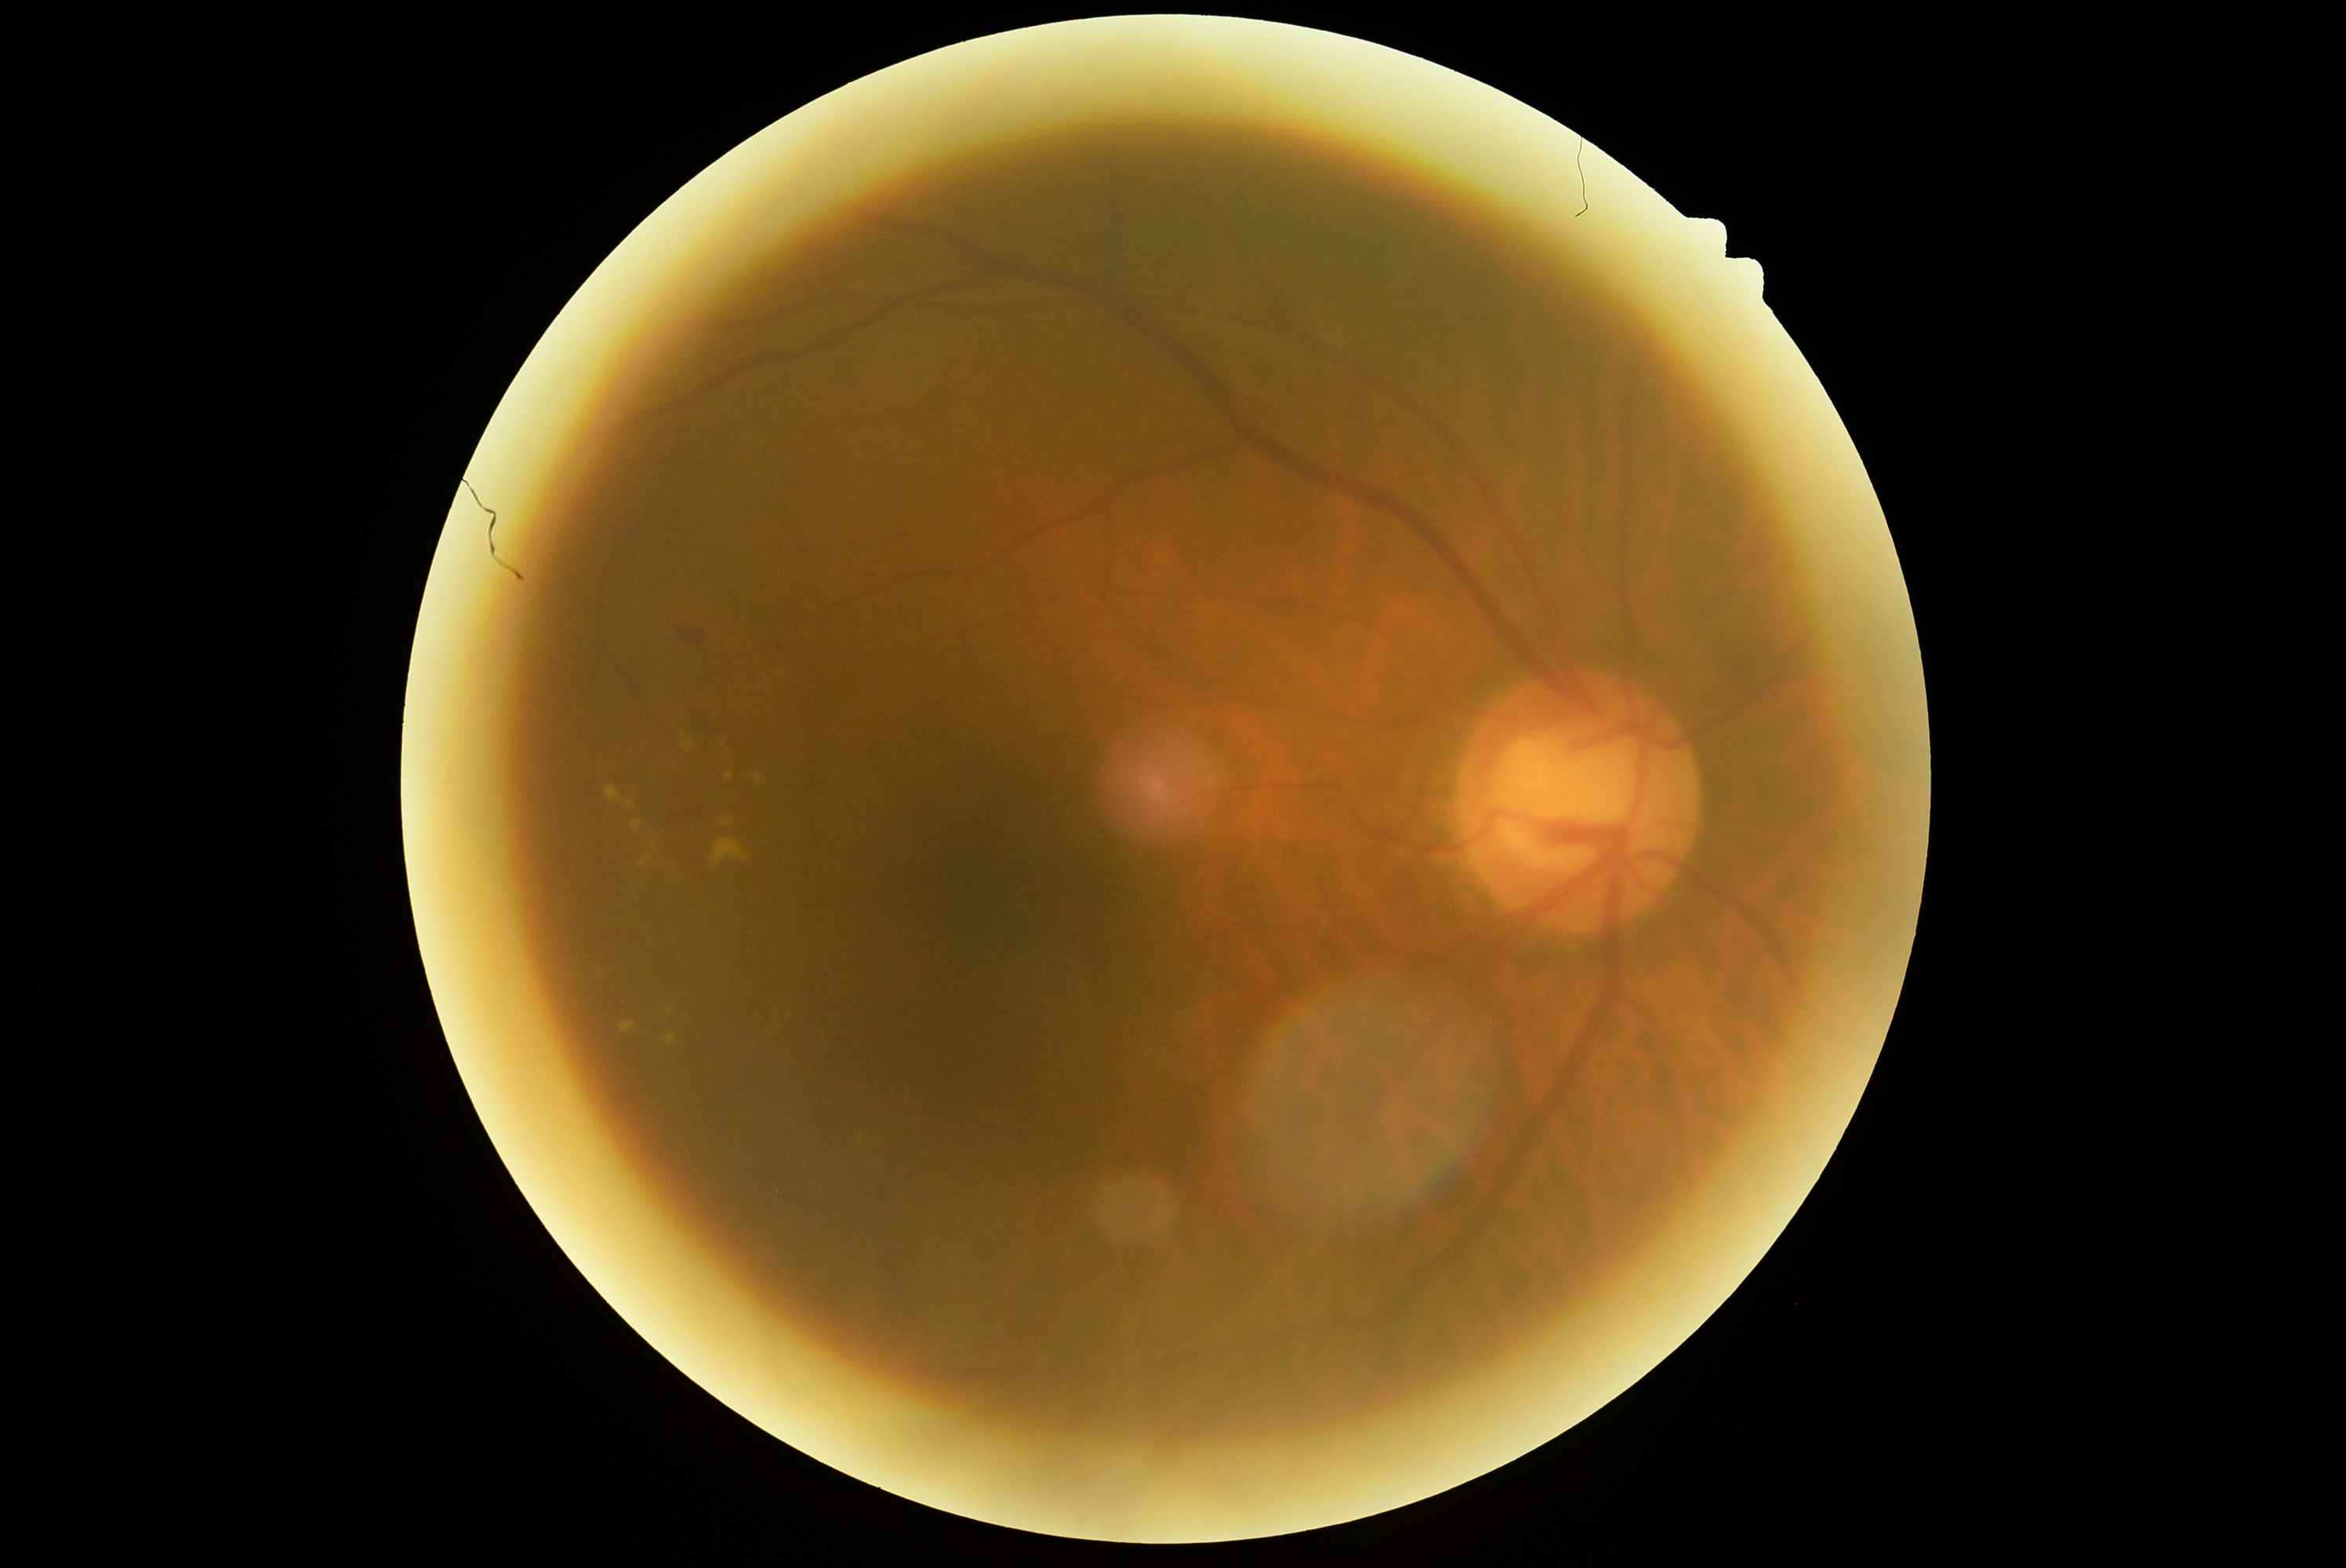

Retinopathy: moderate non-proliferative diabetic retinopathy (grade 2).